Image size 2212x1659; 45-degree field of view: 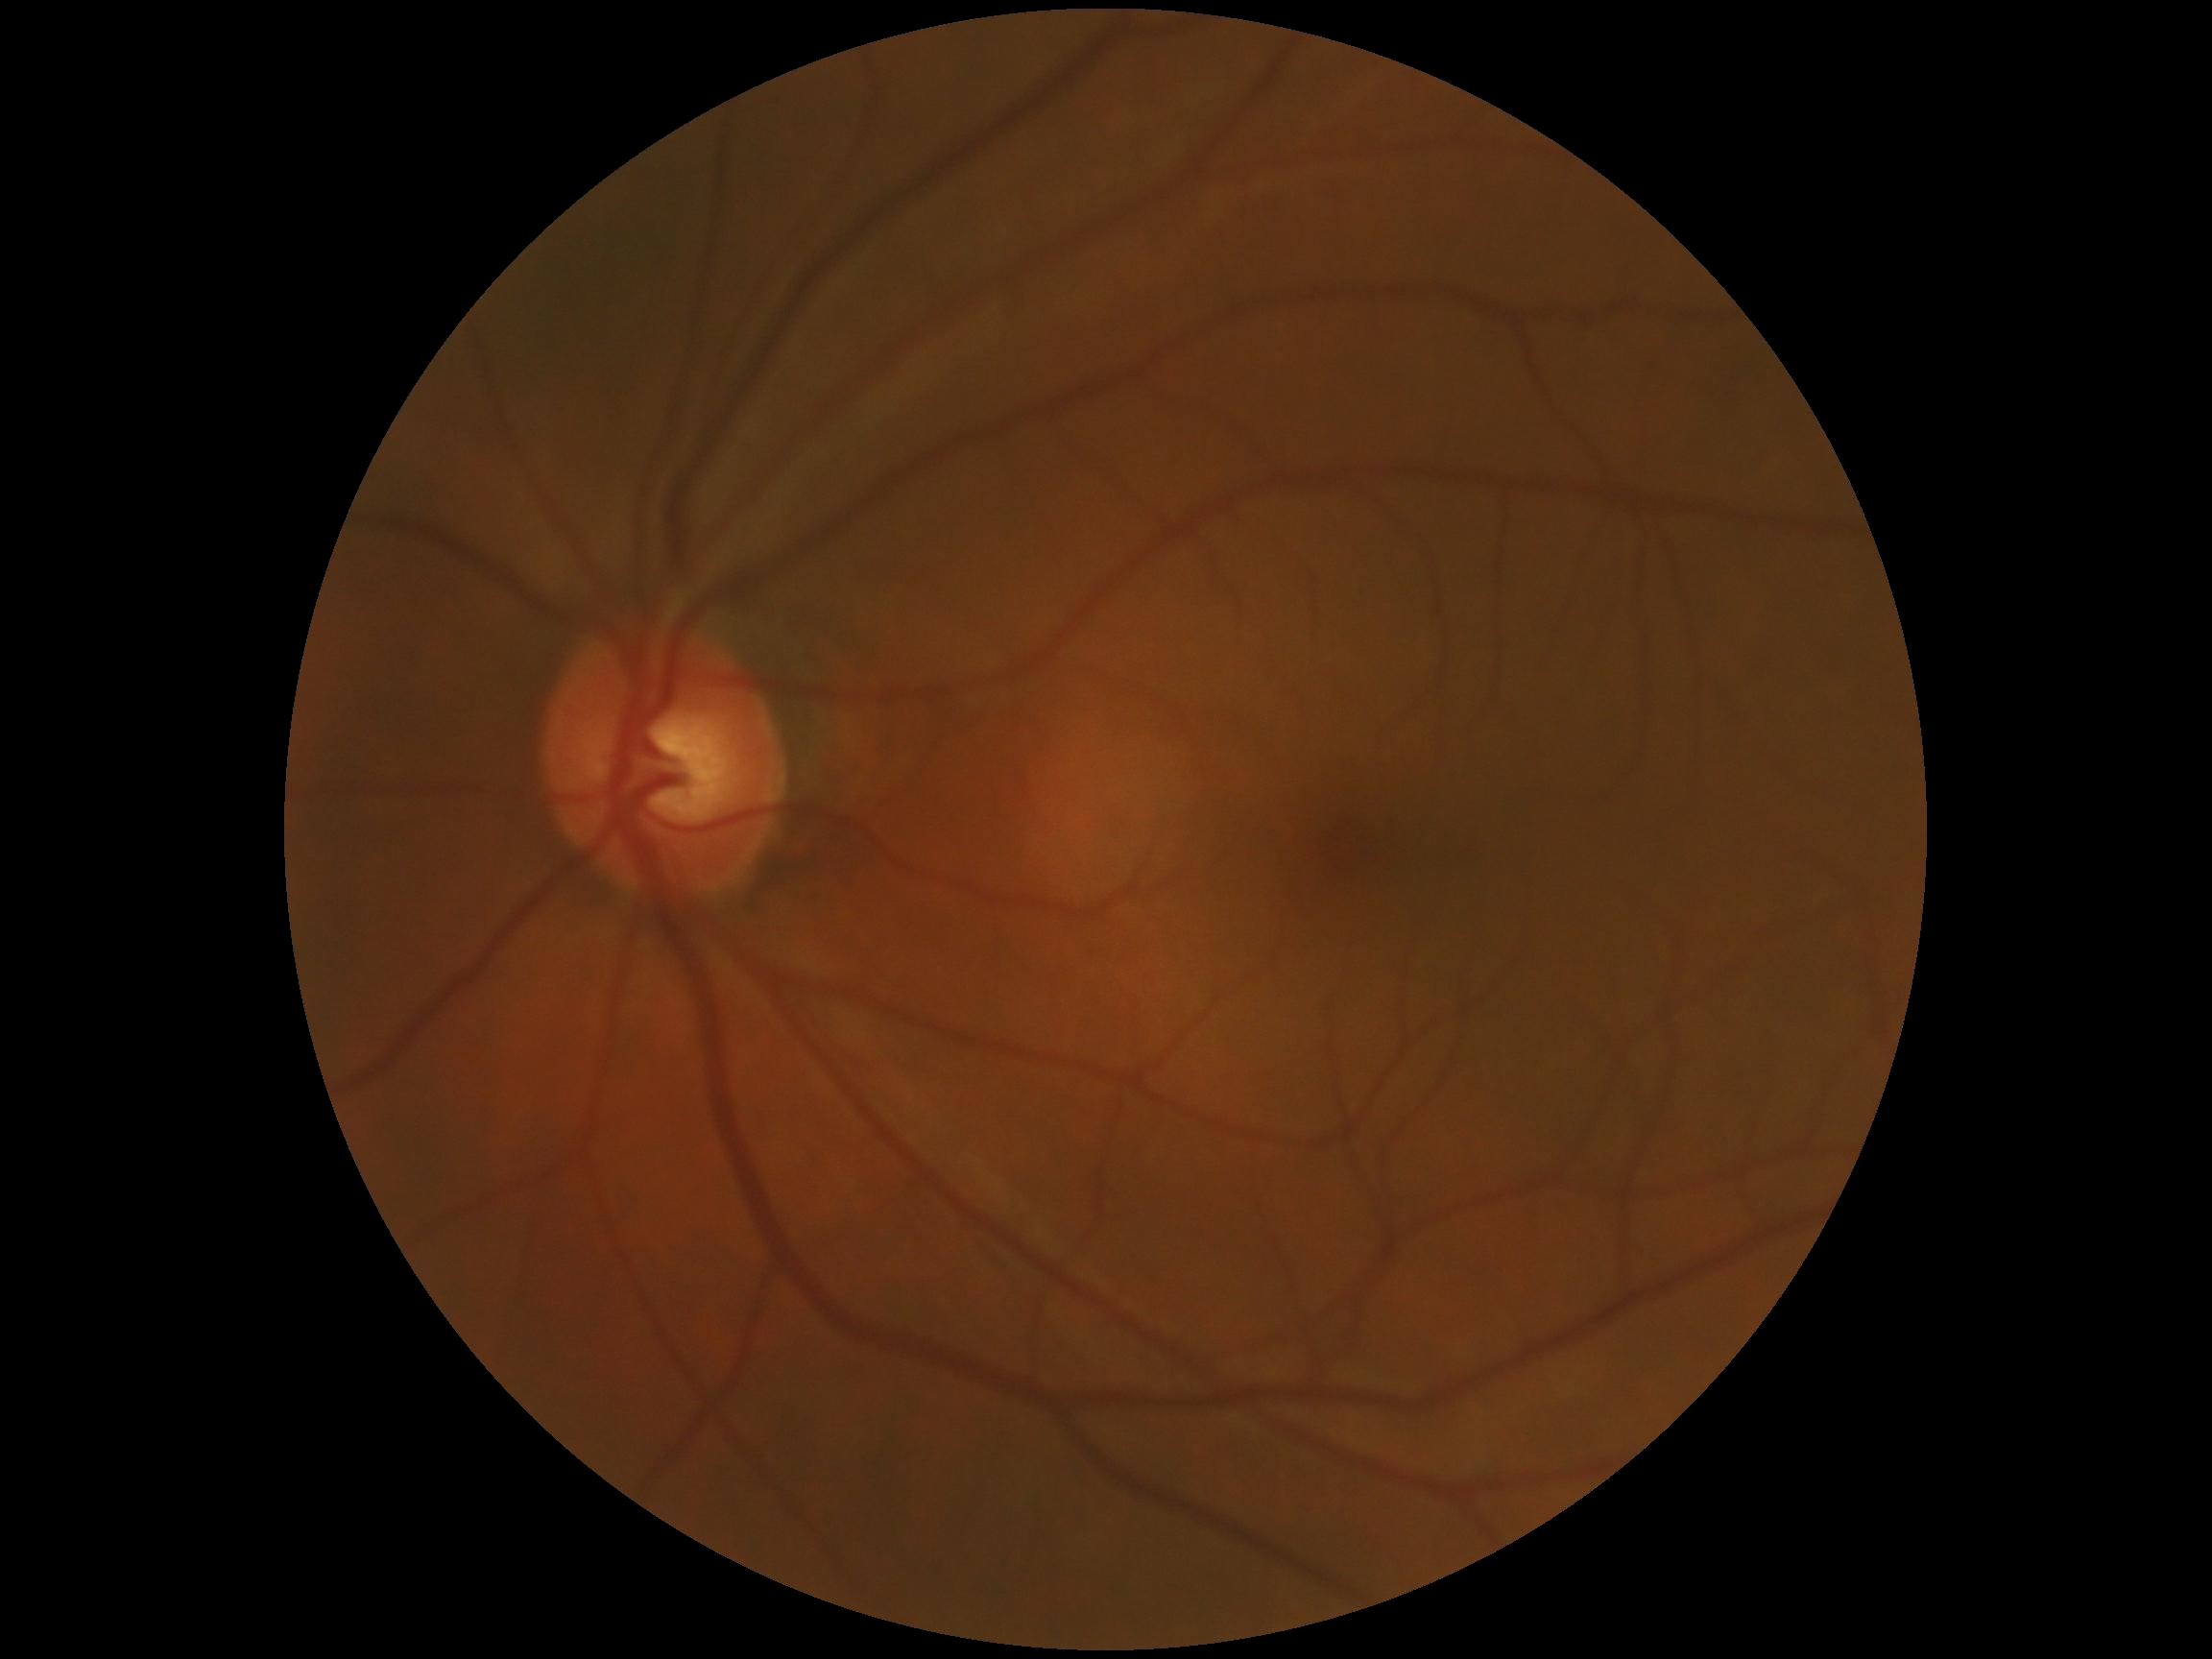
No apparent diabetic retinopathy. DR stage is grade 0 (no apparent retinopathy) — no visible signs of diabetic retinopathy.